Fundus photo; 2352 x 1568 pixels; FOV: 45 degrees
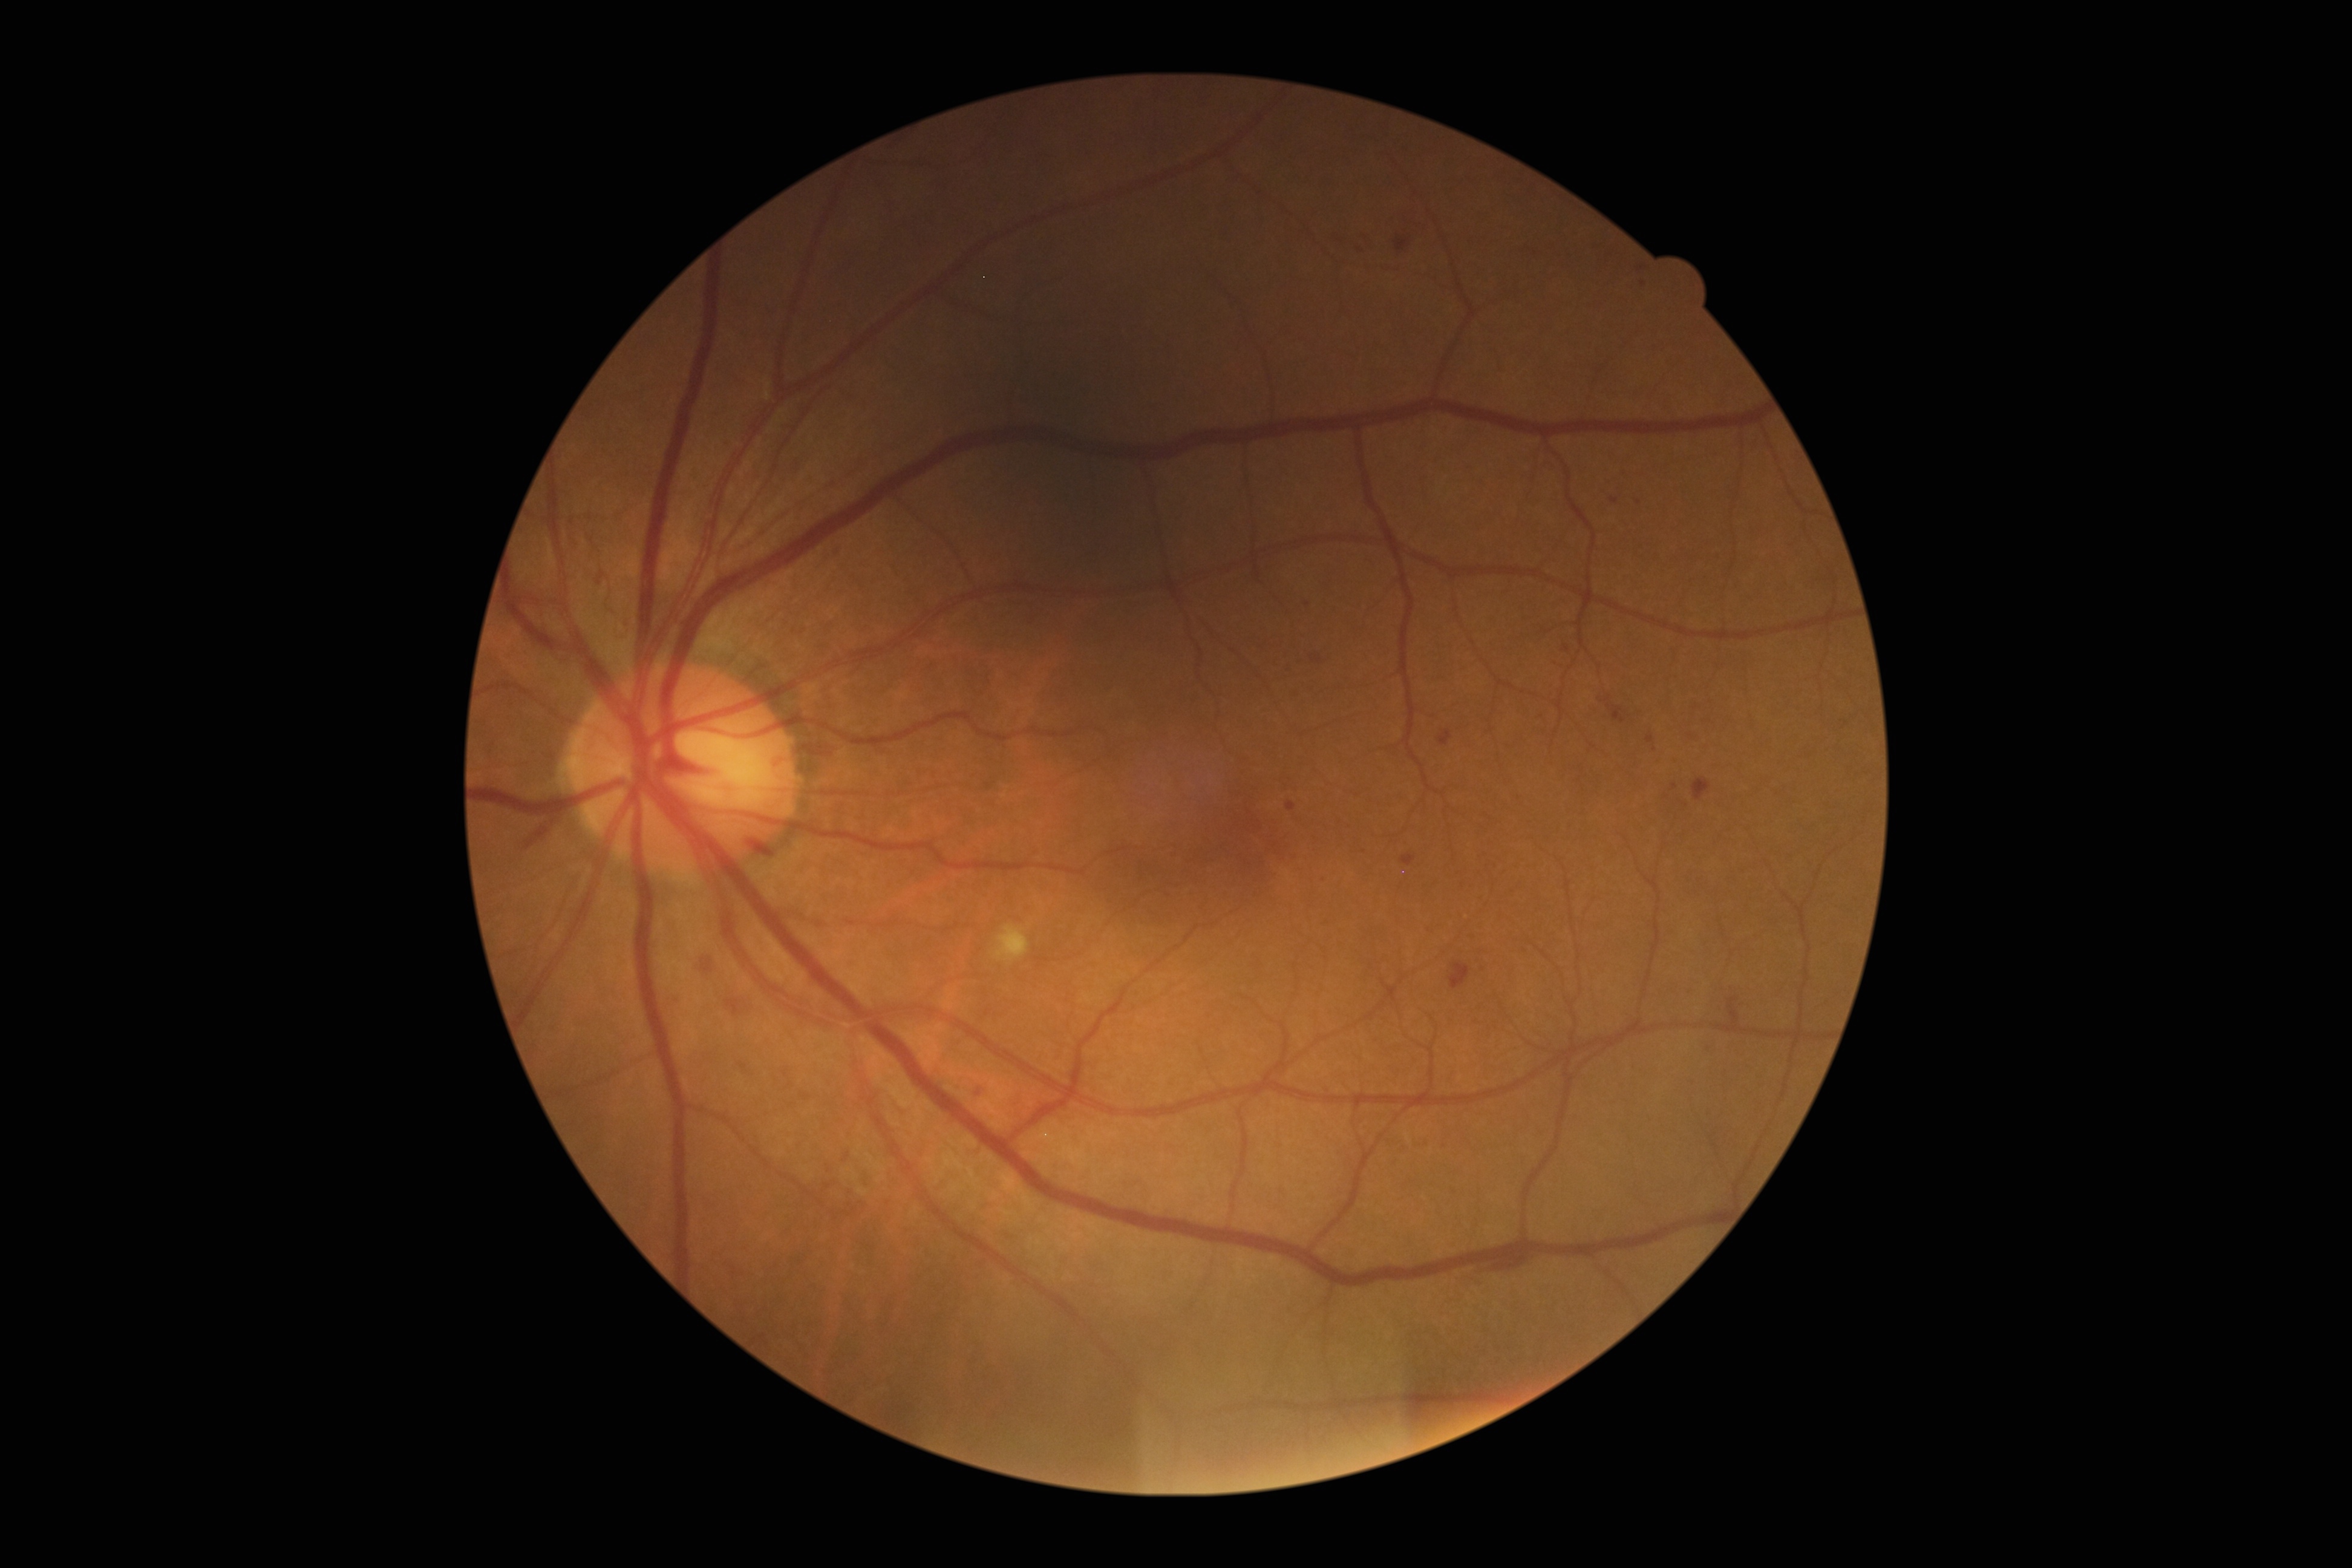
Diabetic retinopathy (DR) is grade 2
Representative lesions:
microaneurysms (MAs) (partial): 1336 234 1344 243; 1400 854 1415 866; 1647 734 1655 743; 1639 267 1647 272; 1311 655 1322 664
Small MAs approximately at Point(1638, 502); Point(1324, 881); Point(828, 1185); Point(1674, 787); Point(1643, 284); Point(1614, 501); Point(1691, 737)